Acquired with a Nidek AFC-330.
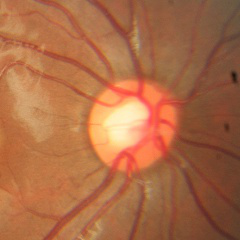
Glaucoma stage = no evidence of glaucoma.